Wide-field contact fundus photograph of an infant; 640x480:
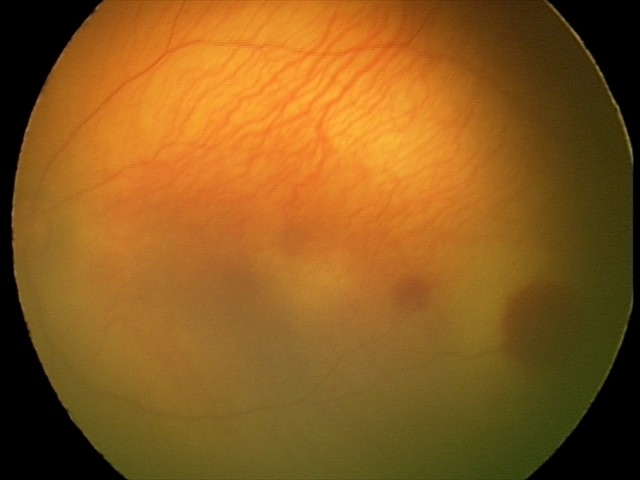 Q: What was the screening finding?
A: retinal hemorrhages